848x848. NIDEK AFC-230 fundus camera — 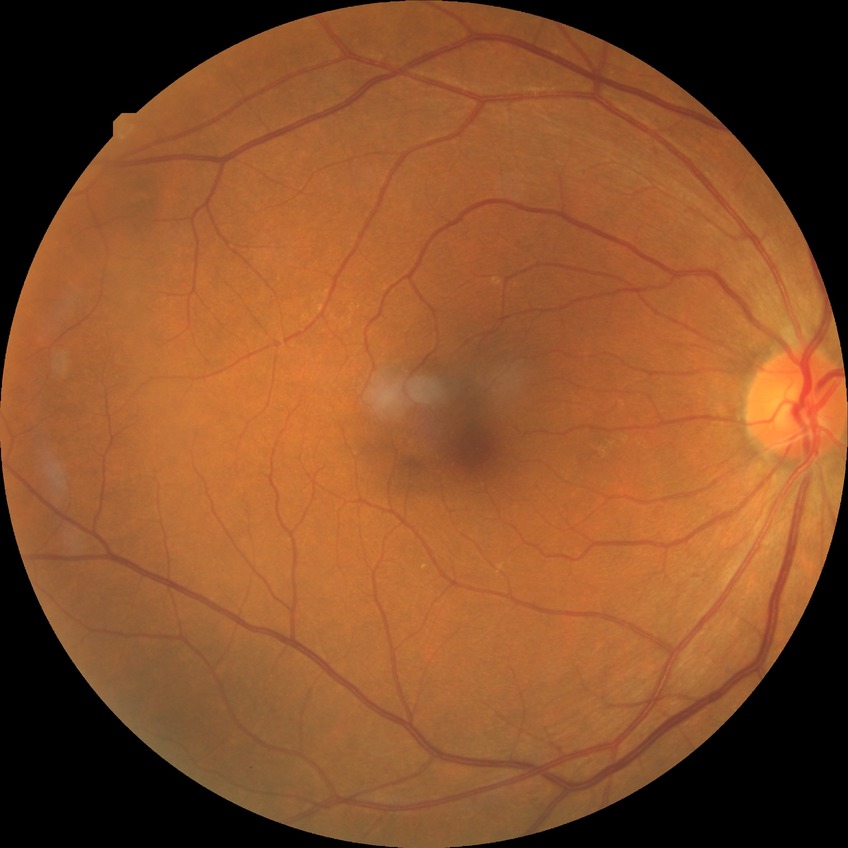 {
  "davis_grade": "SDR (simple diabetic retinopathy)"
}